2346x1568: 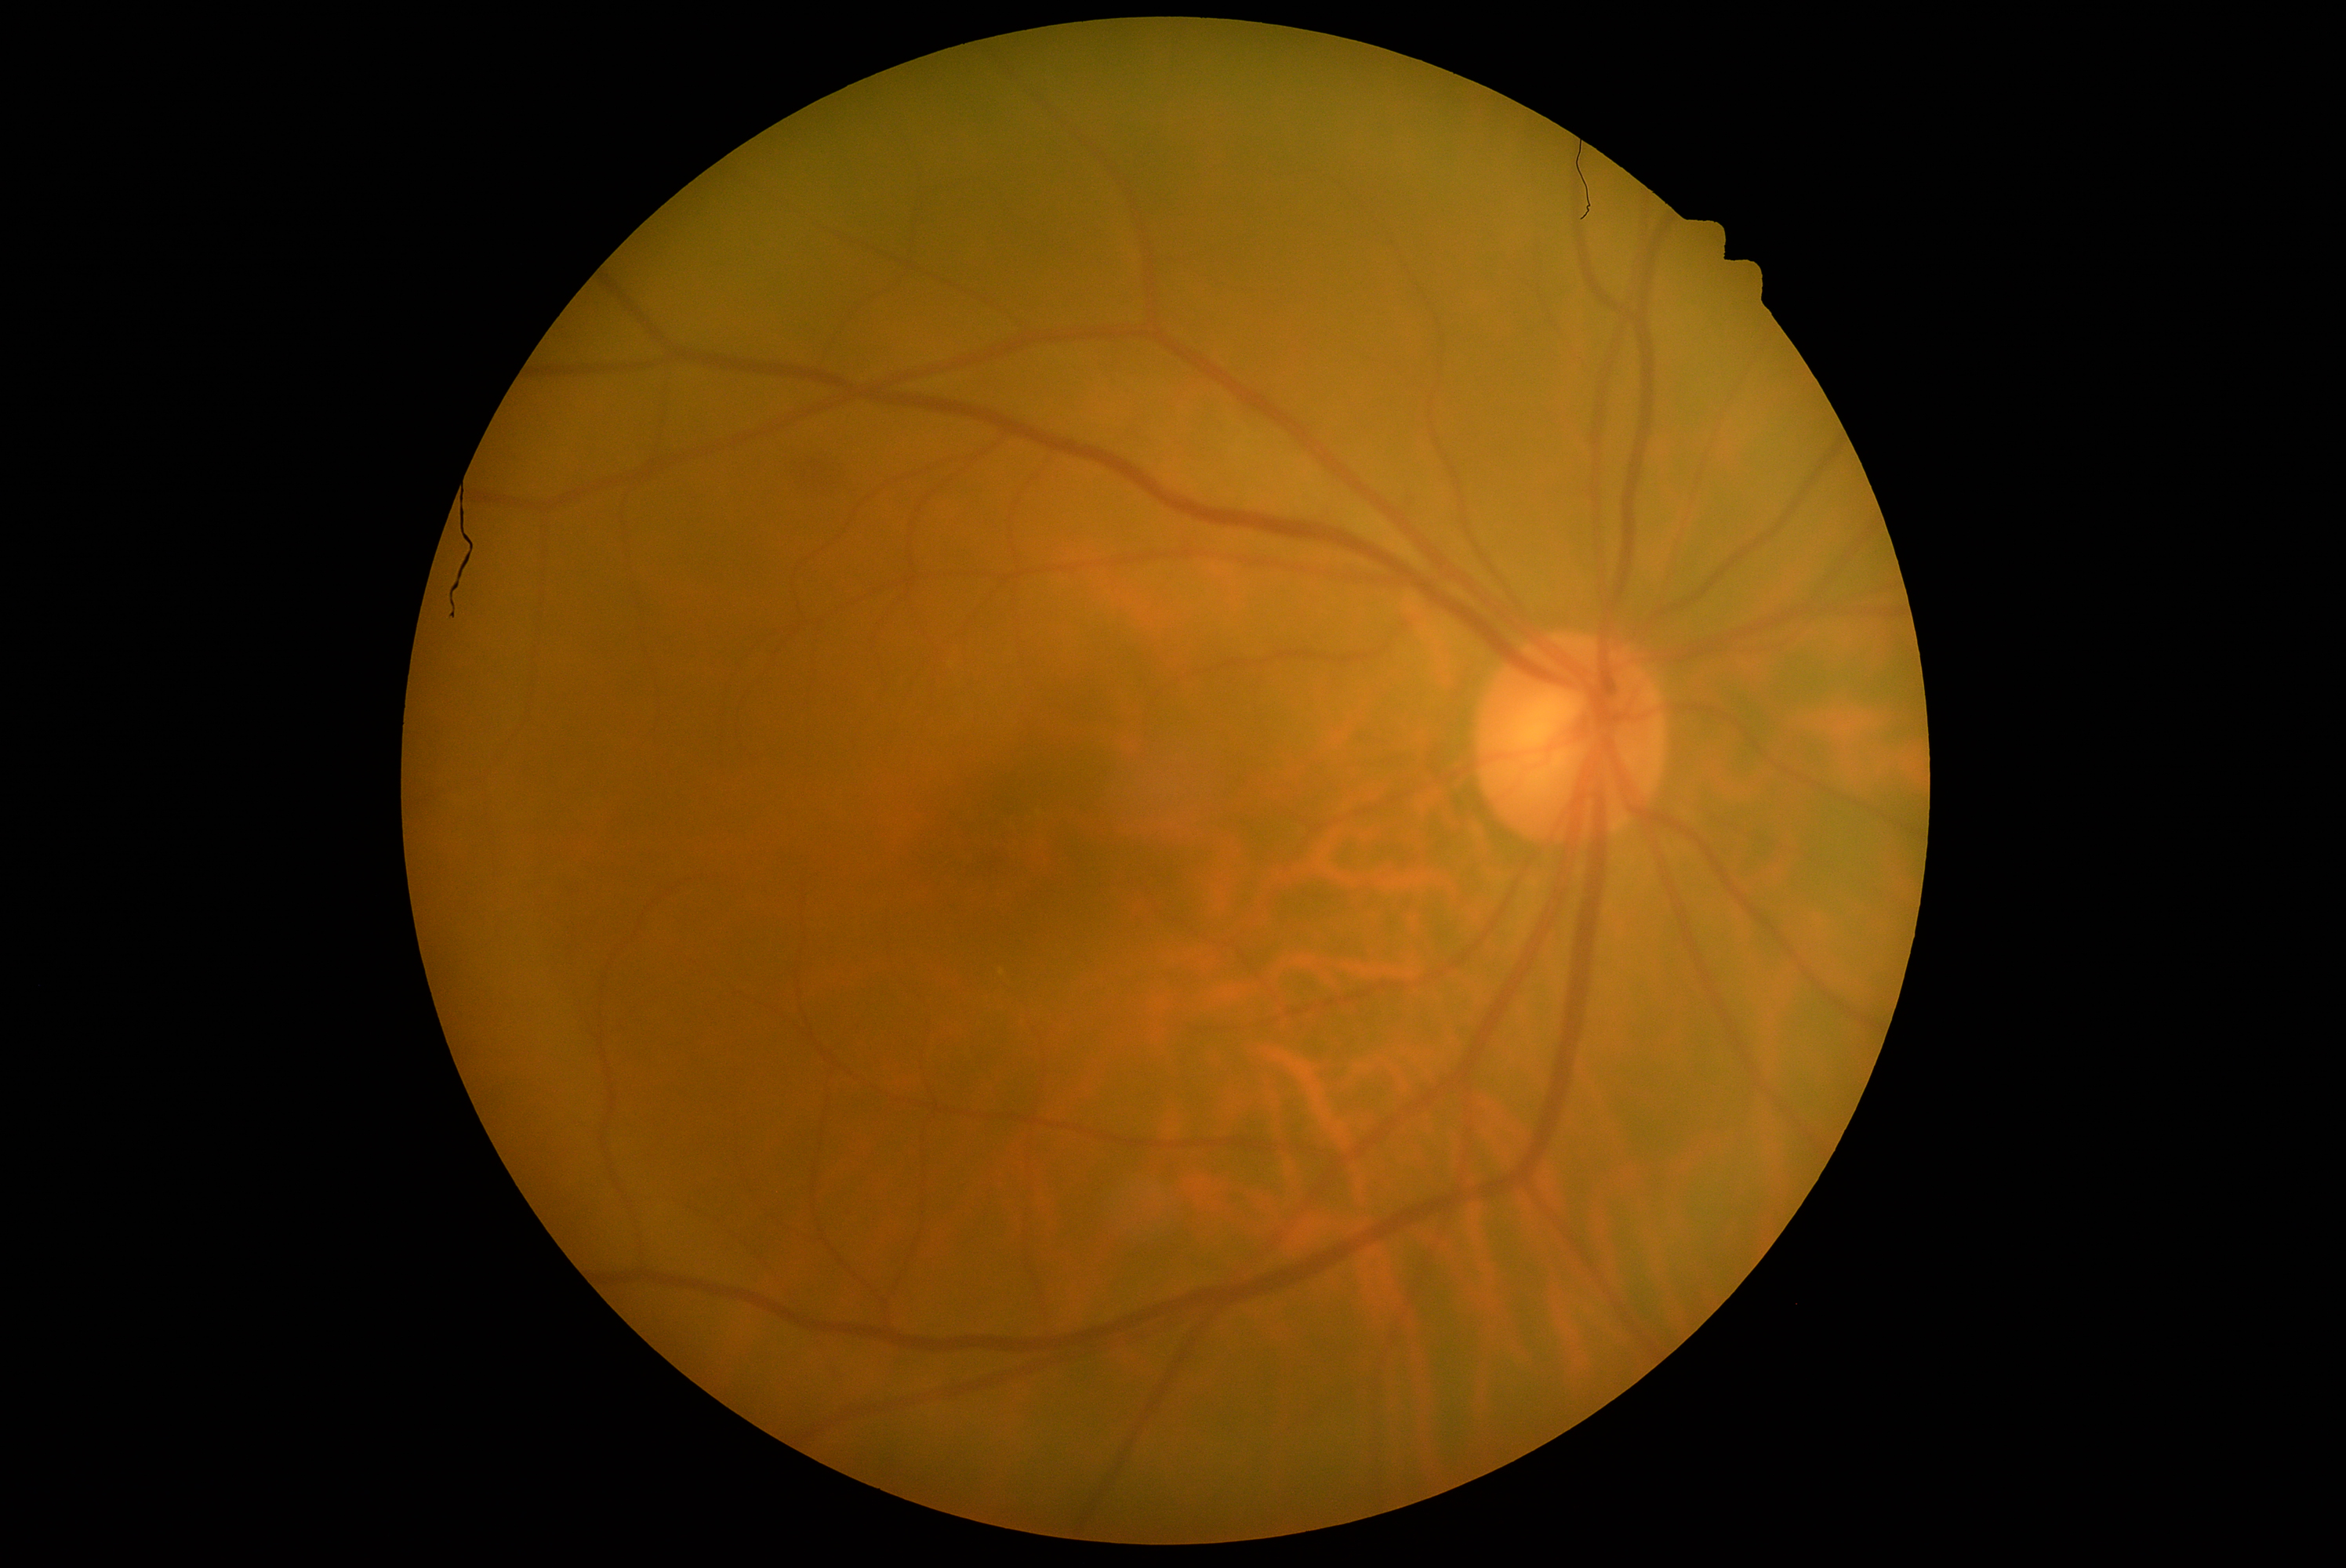

DR impression = no apparent DR
DR = grade 0 (no apparent retinopathy) — no visible signs of diabetic retinopathy